Posterior pole color fundus photograph · image size 848x848 · 45 degree fundus photograph — 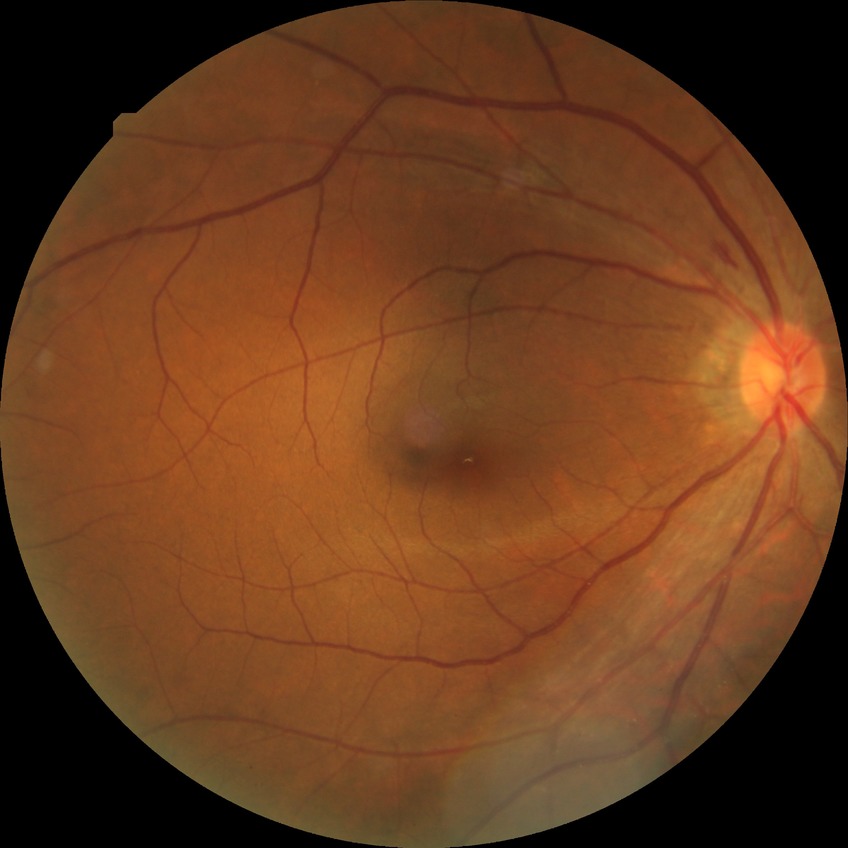 DR class: non-proliferative diabetic retinopathy; diabetic retinopathy (DR): SDR (simple diabetic retinopathy).